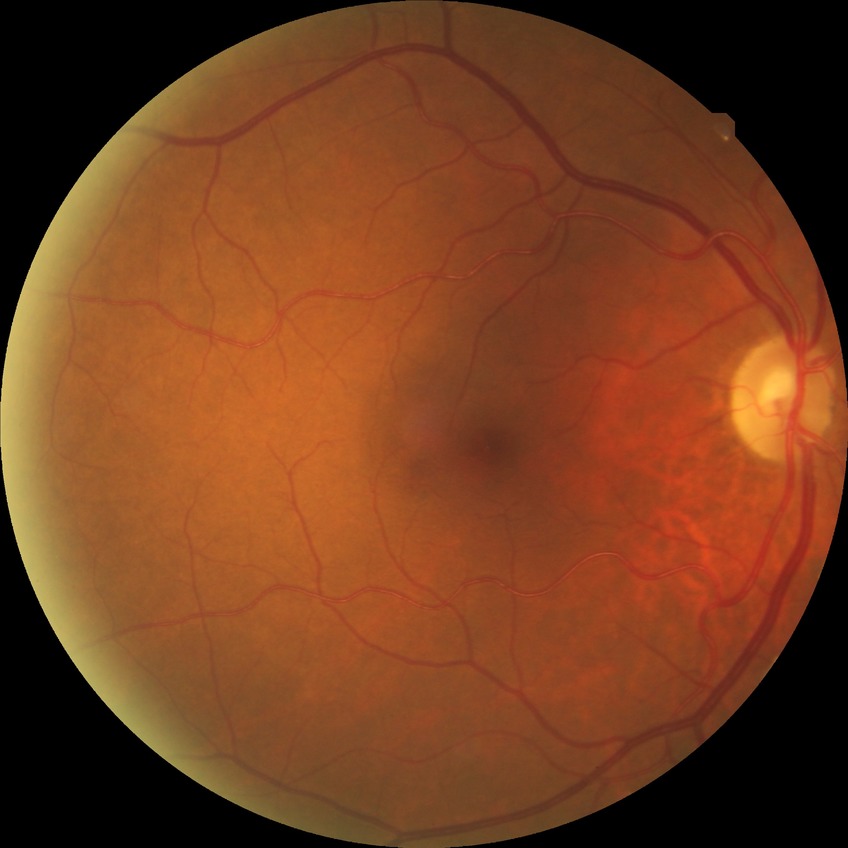

diabetic retinopathy (DR): no diabetic retinopathy (NDR).